Color fundus photograph:
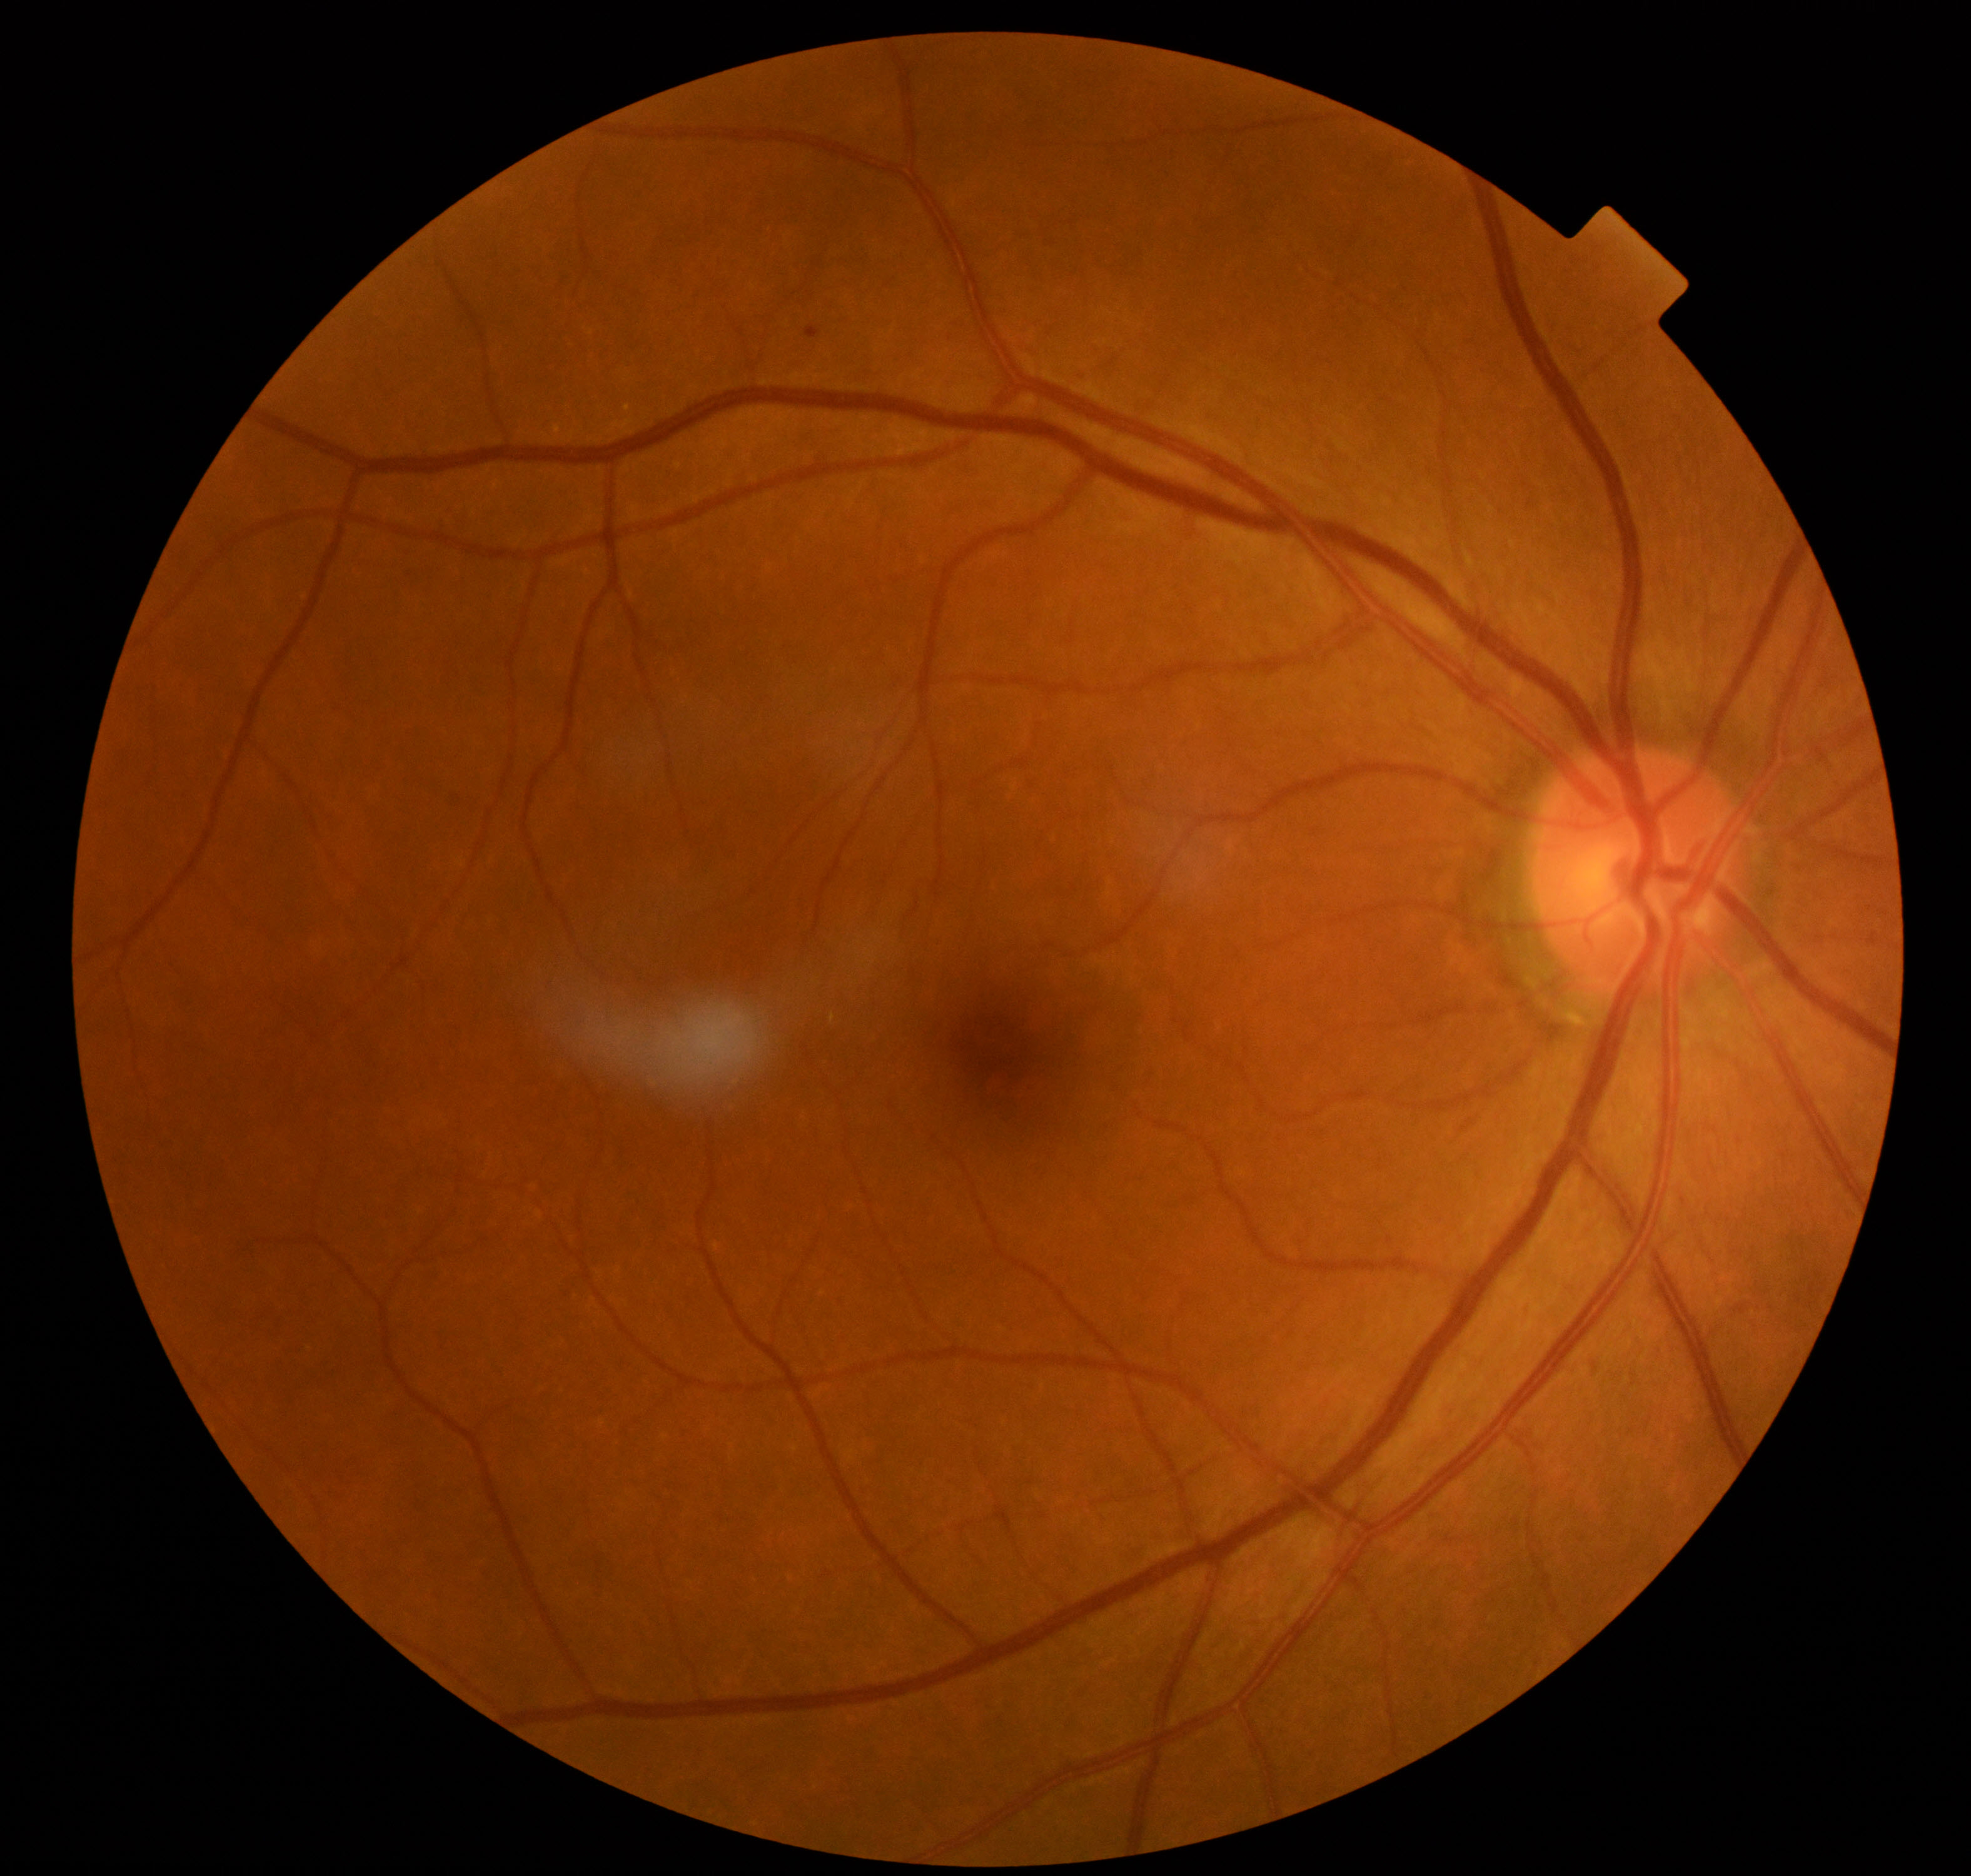
Appearance consistent with mild non-proliferative diabetic retinopathy. Characterized by microaneurysms only (International Classification of Diabetic Retinopathy, 2017).